848 by 848 pixels; NIDEK AFC-230; without pupil dilation; diabetic retinopathy graded by the modified Davis classification: 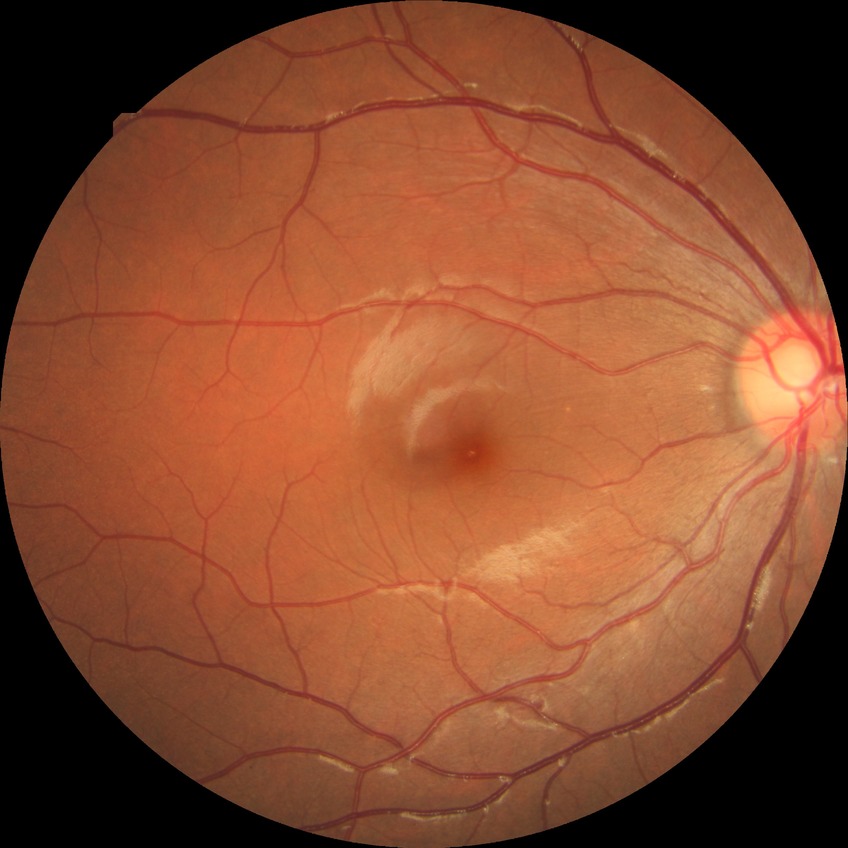

DR: SDR.